Non-mydriatic:
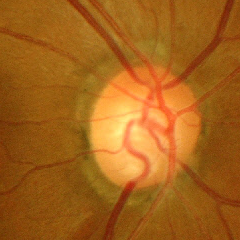
Optic disc appearance consistent with severe glaucomatous damage.